Fundus photo; 45-degree field of view.
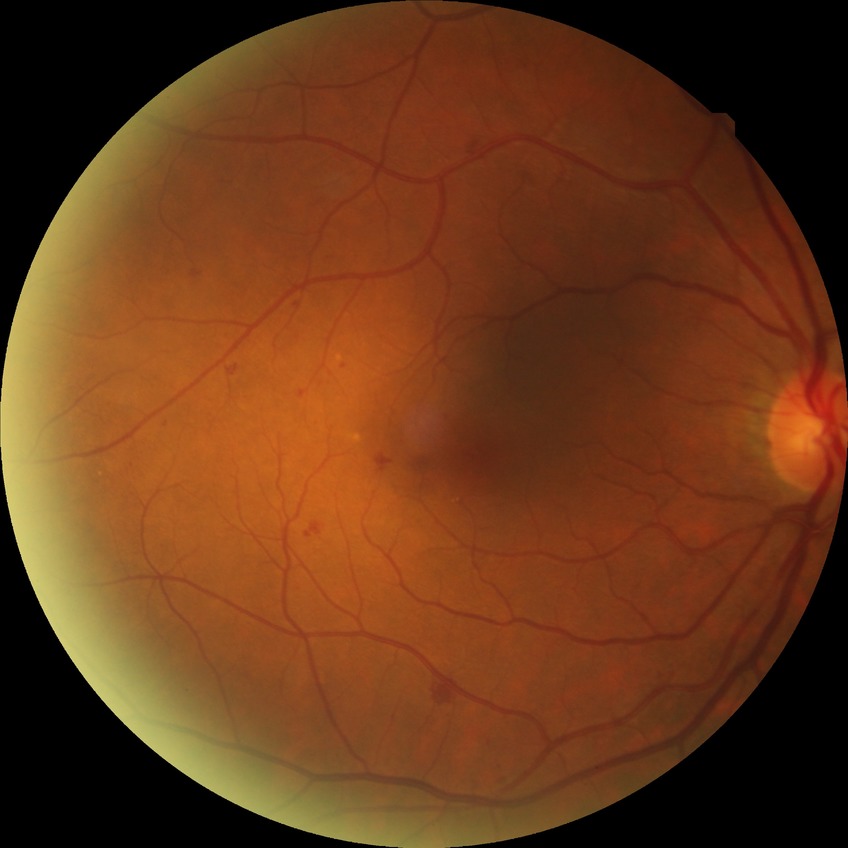
Retinopathy stage is simple diabetic retinopathy.